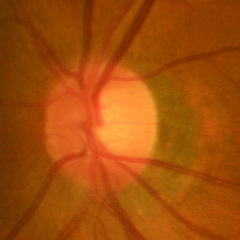 Q: What is the glaucoma diagnosis?
A: Early glaucomatous changes. Diagnostic criteria: glaucomatous retinal nerve fiber layer defects on red-free fundus photography without visual field defects.